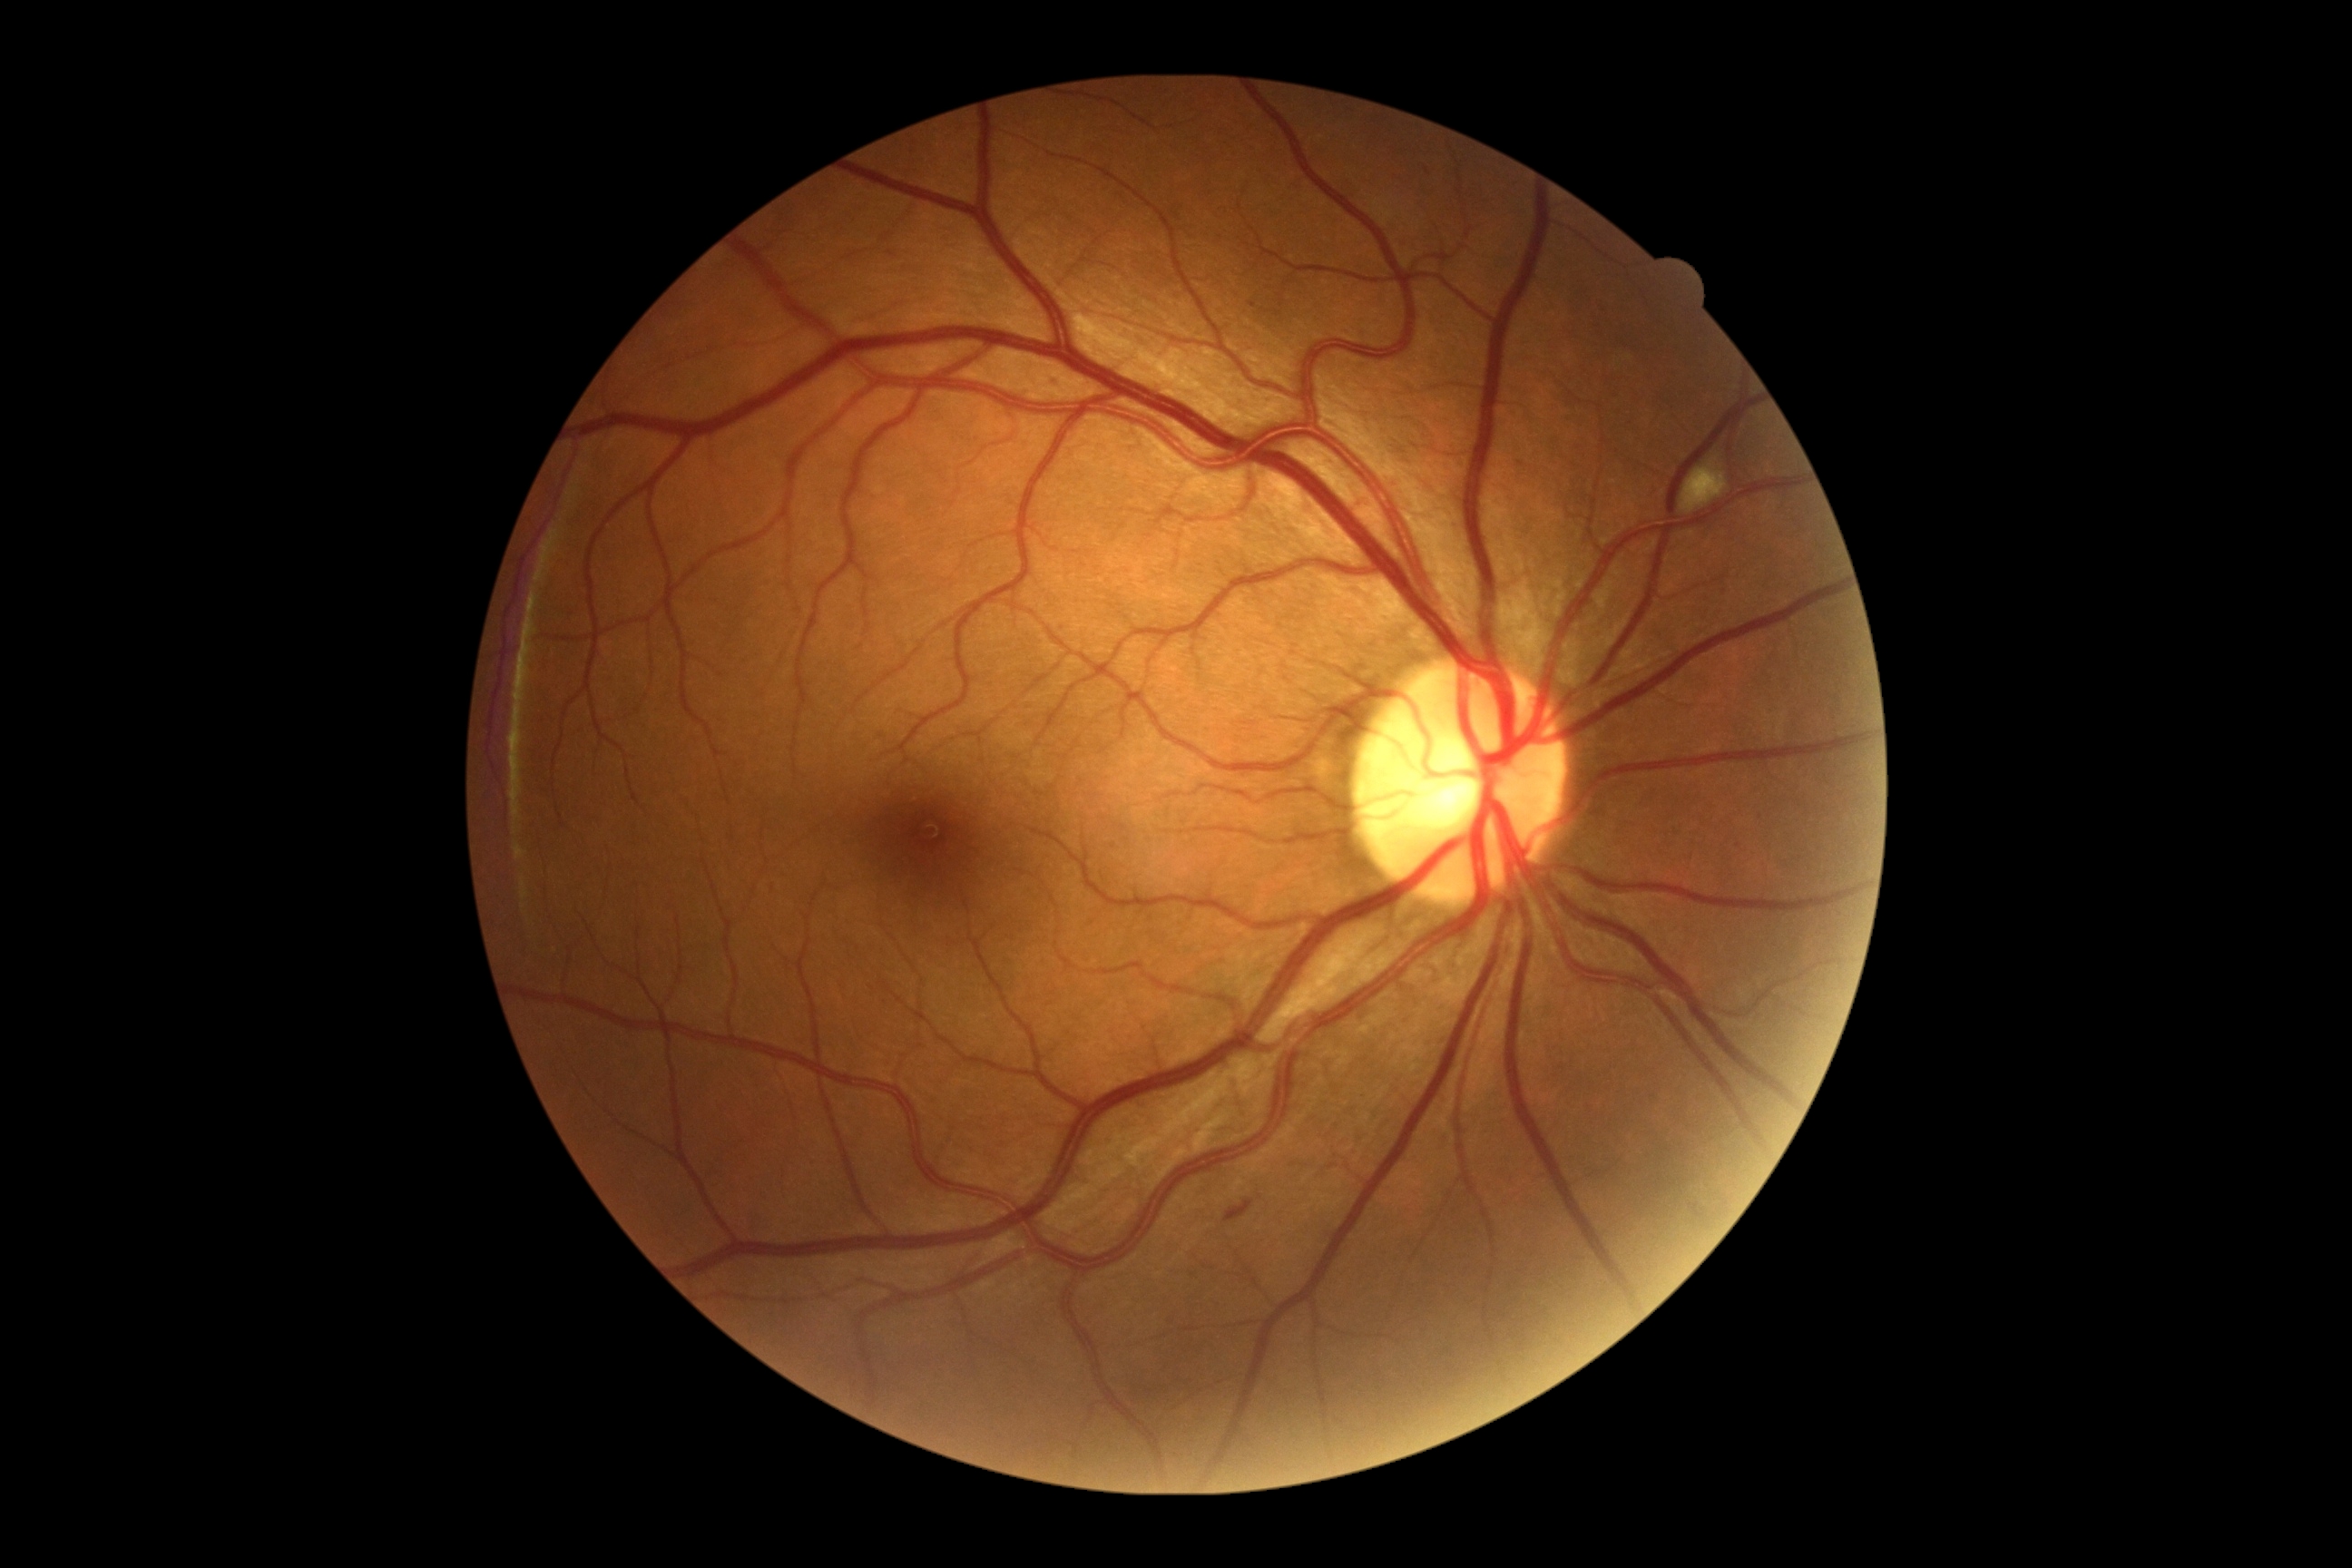
DR severity: moderate NPDR (grade 2) — more than just microaneurysms but less than severe NPDR.